45° field of view
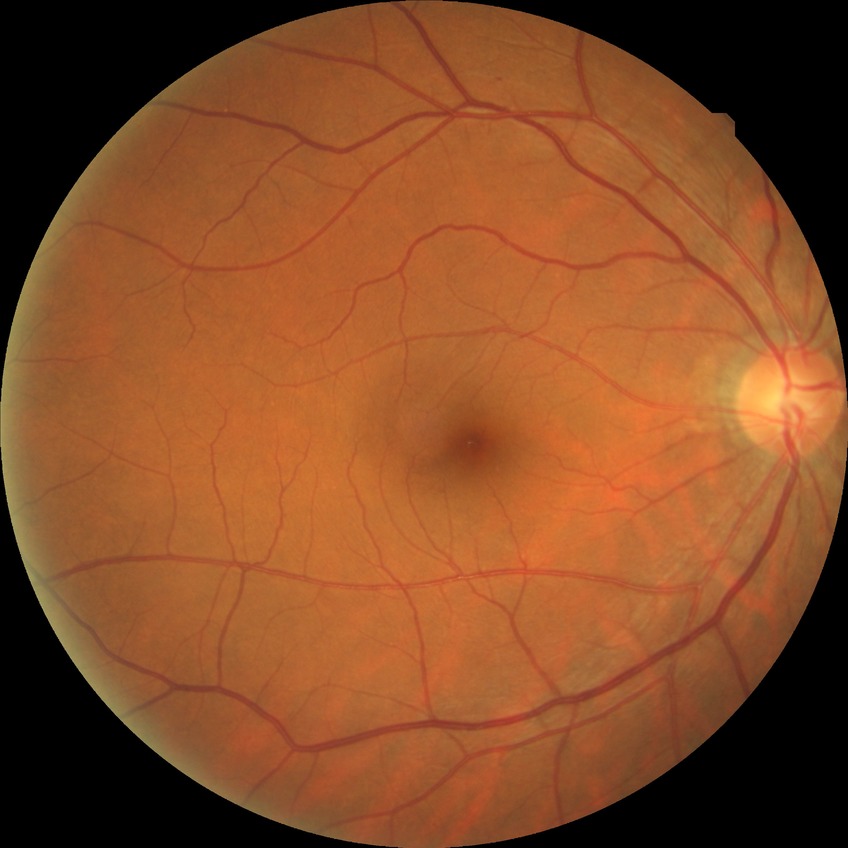   davis_grade: simple diabetic retinopathy